1920x1088. 45° field of view
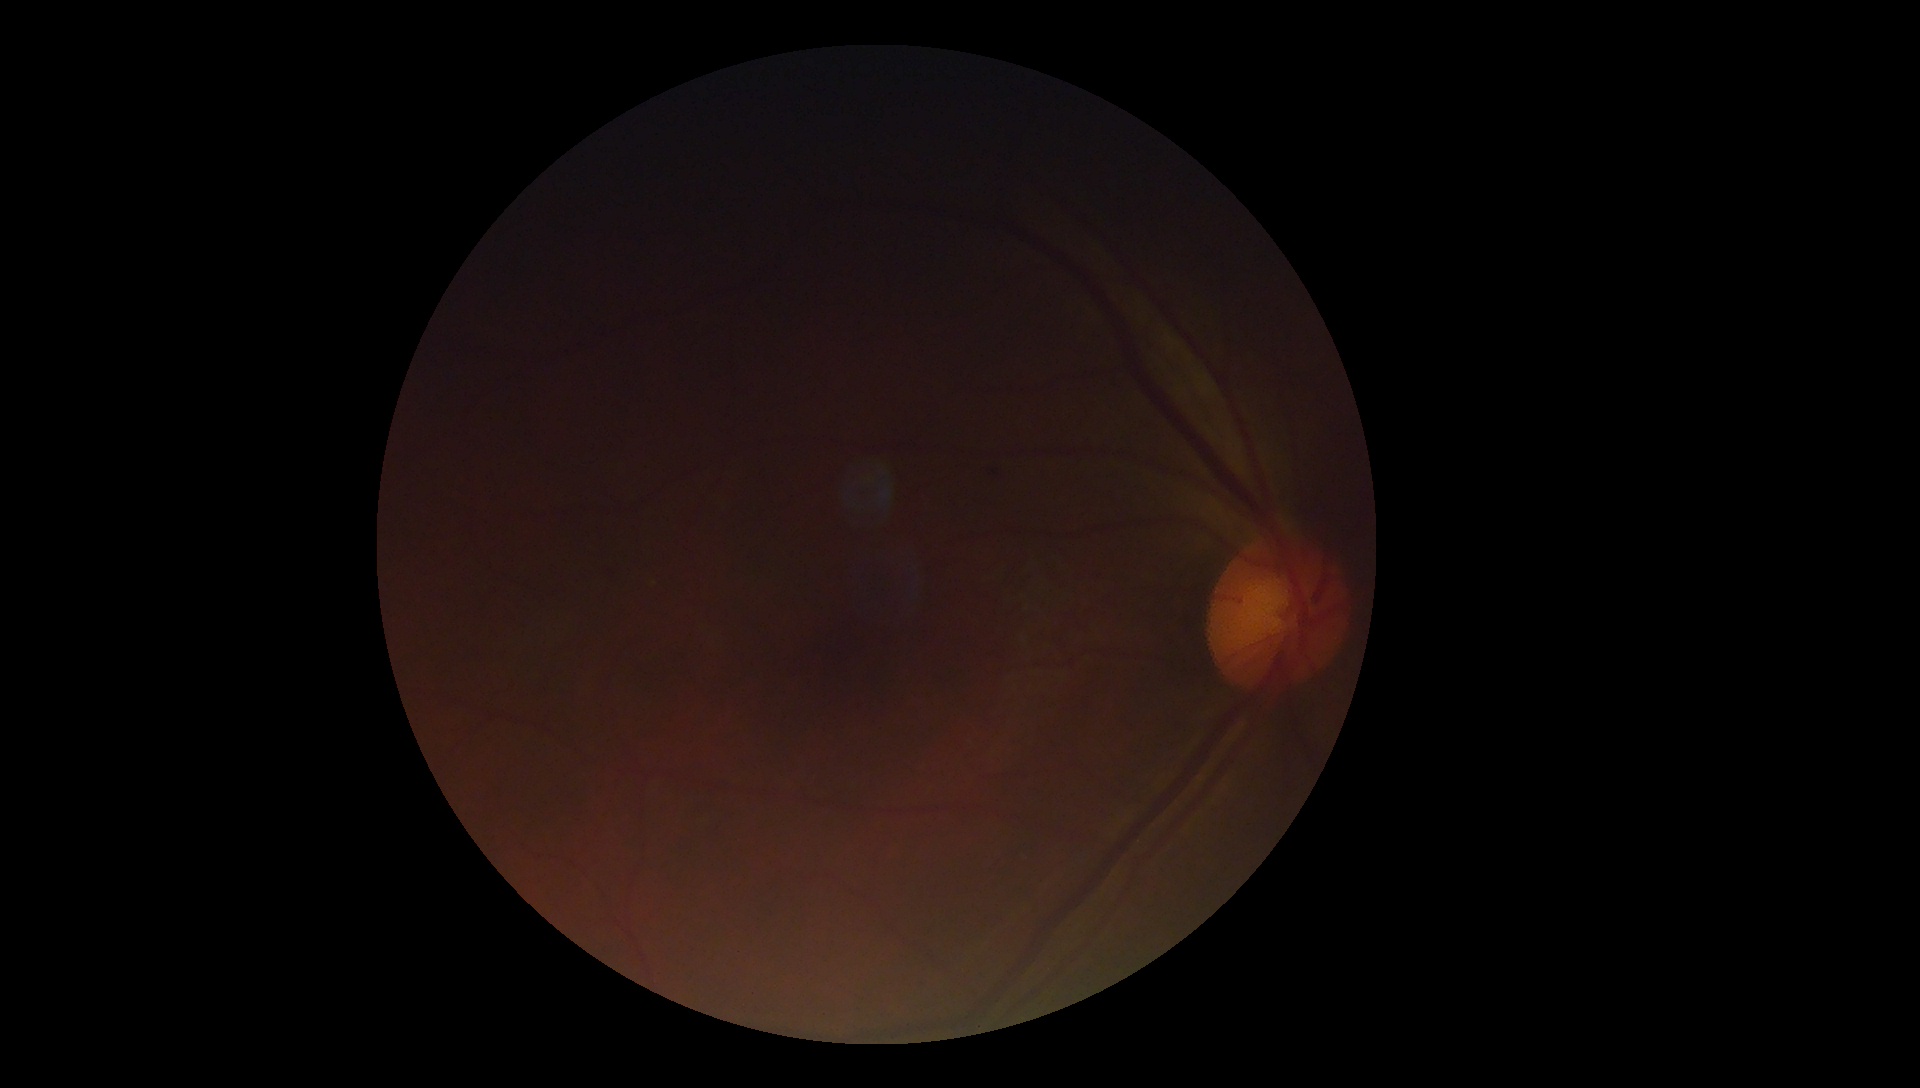
Diabetic retinopathy severity is grade 1.